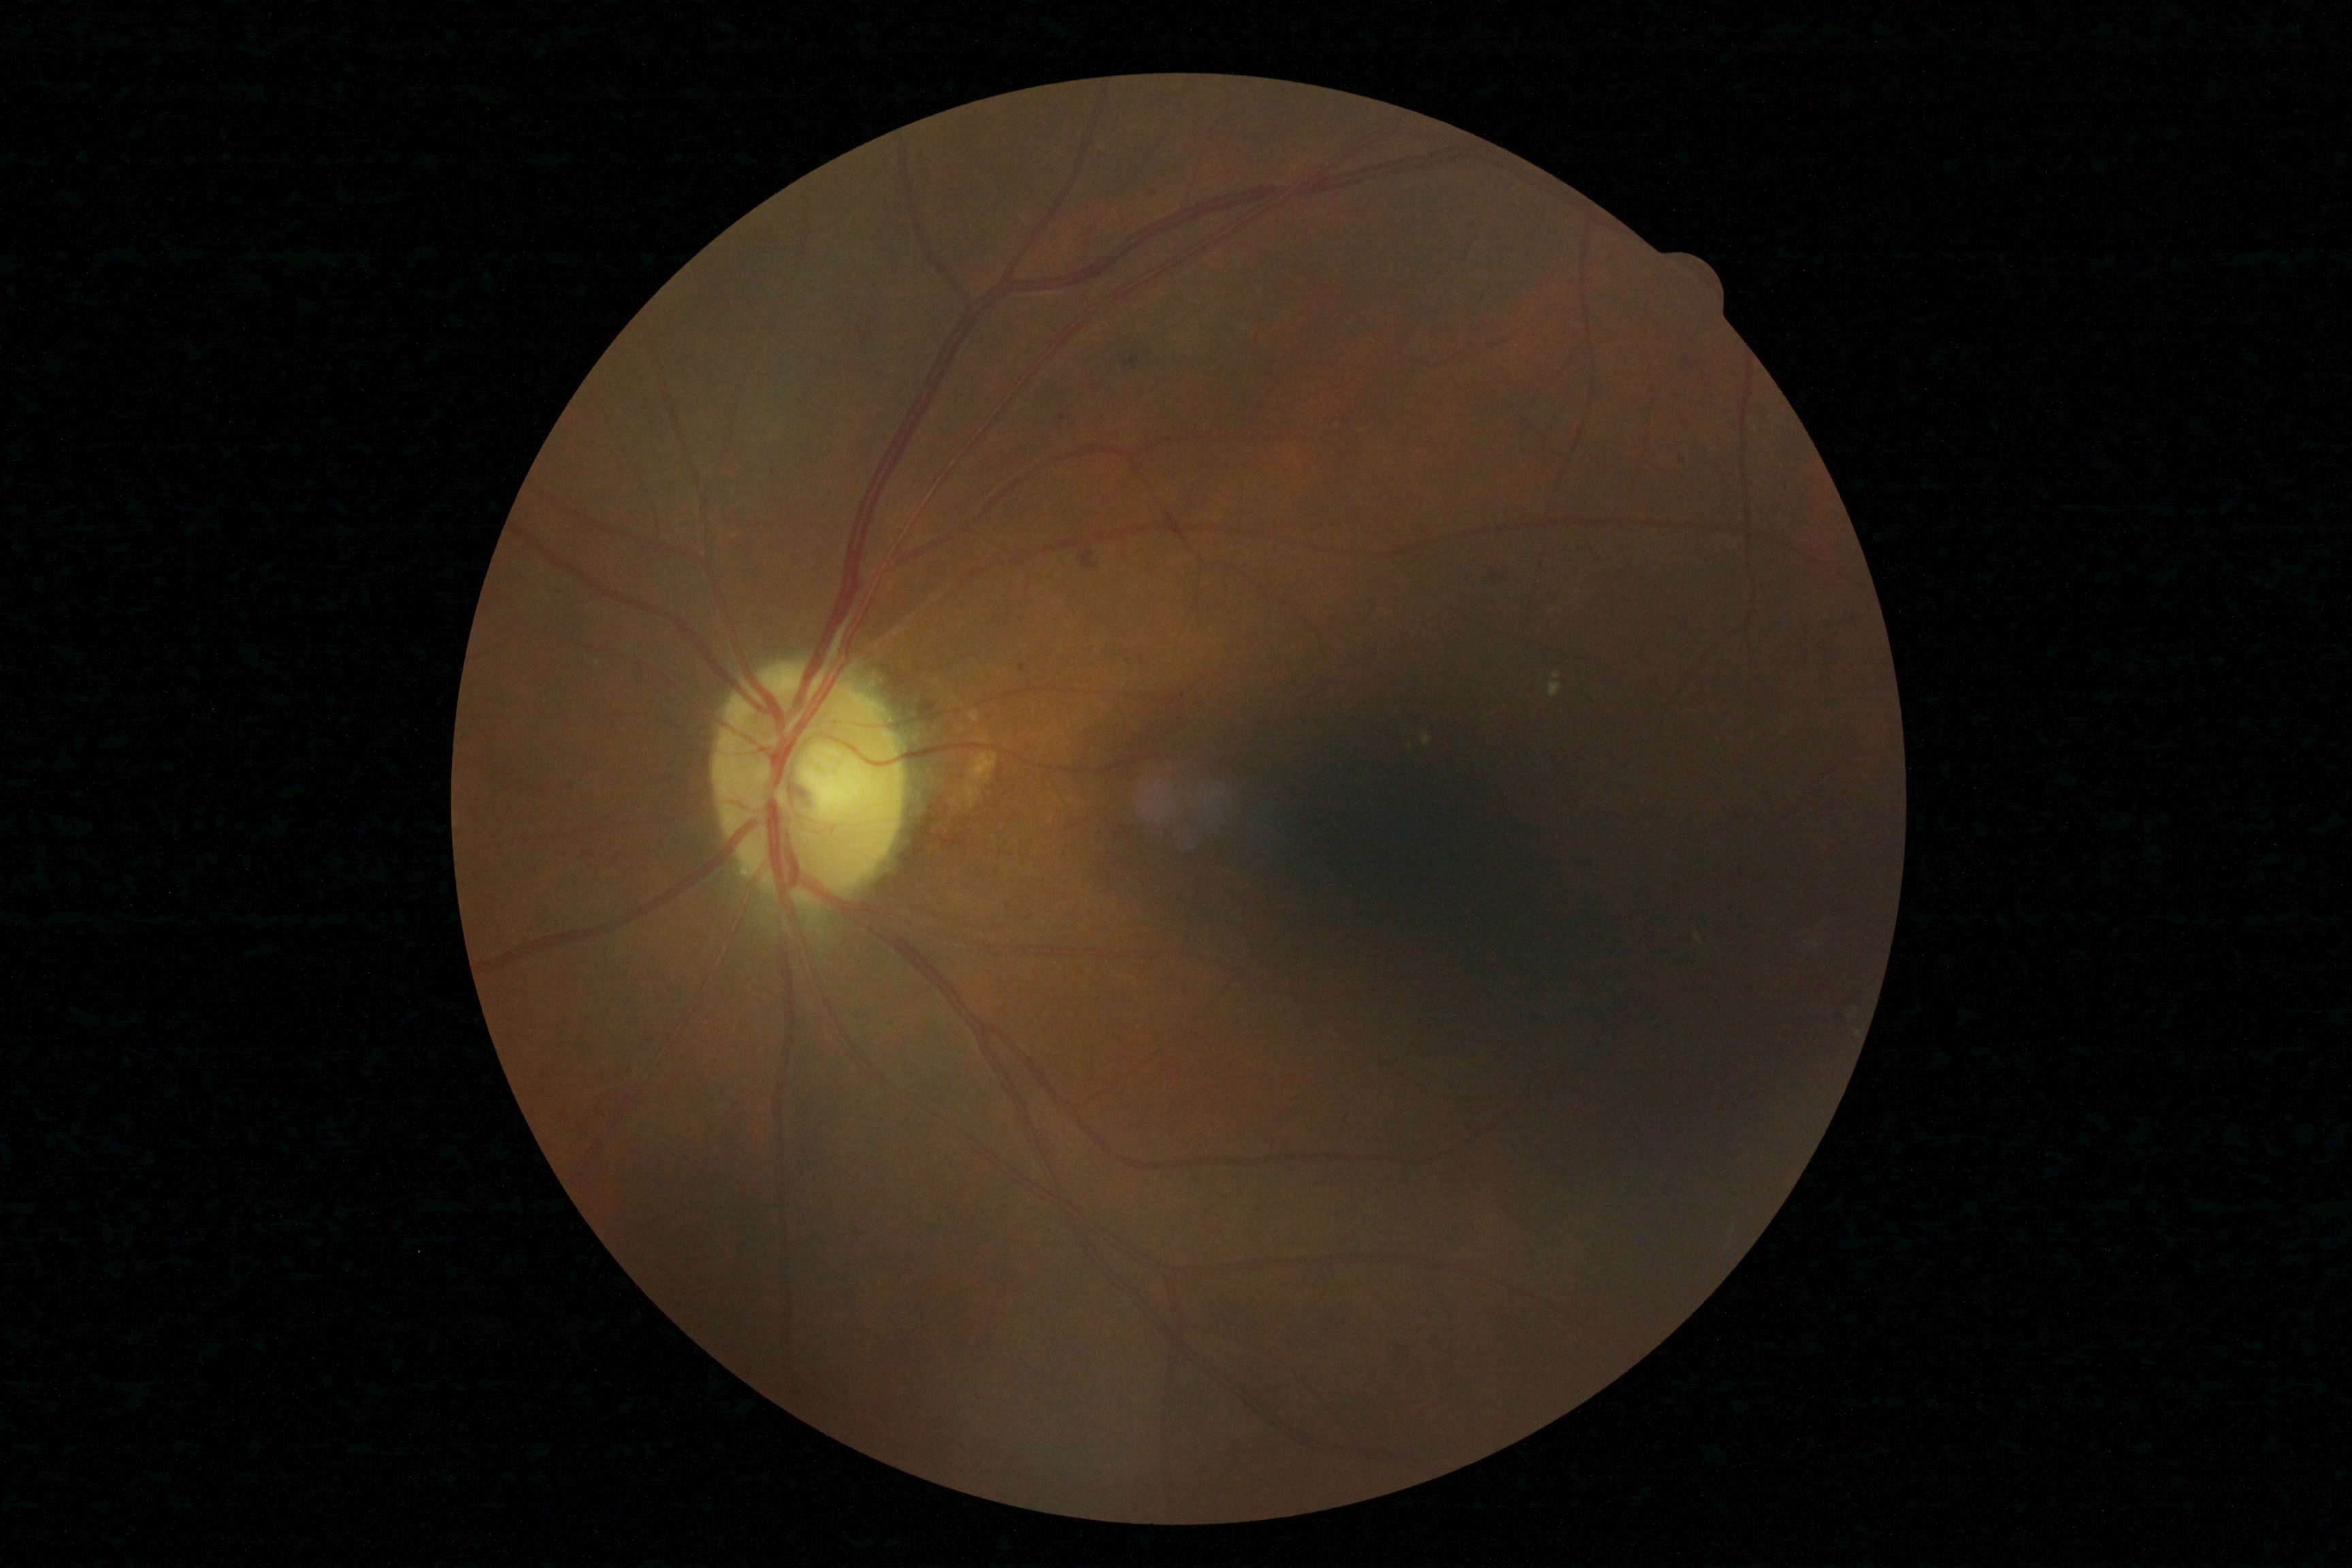

  dr_grade: moderate non-proliferative diabetic retinopathy (grade 2)